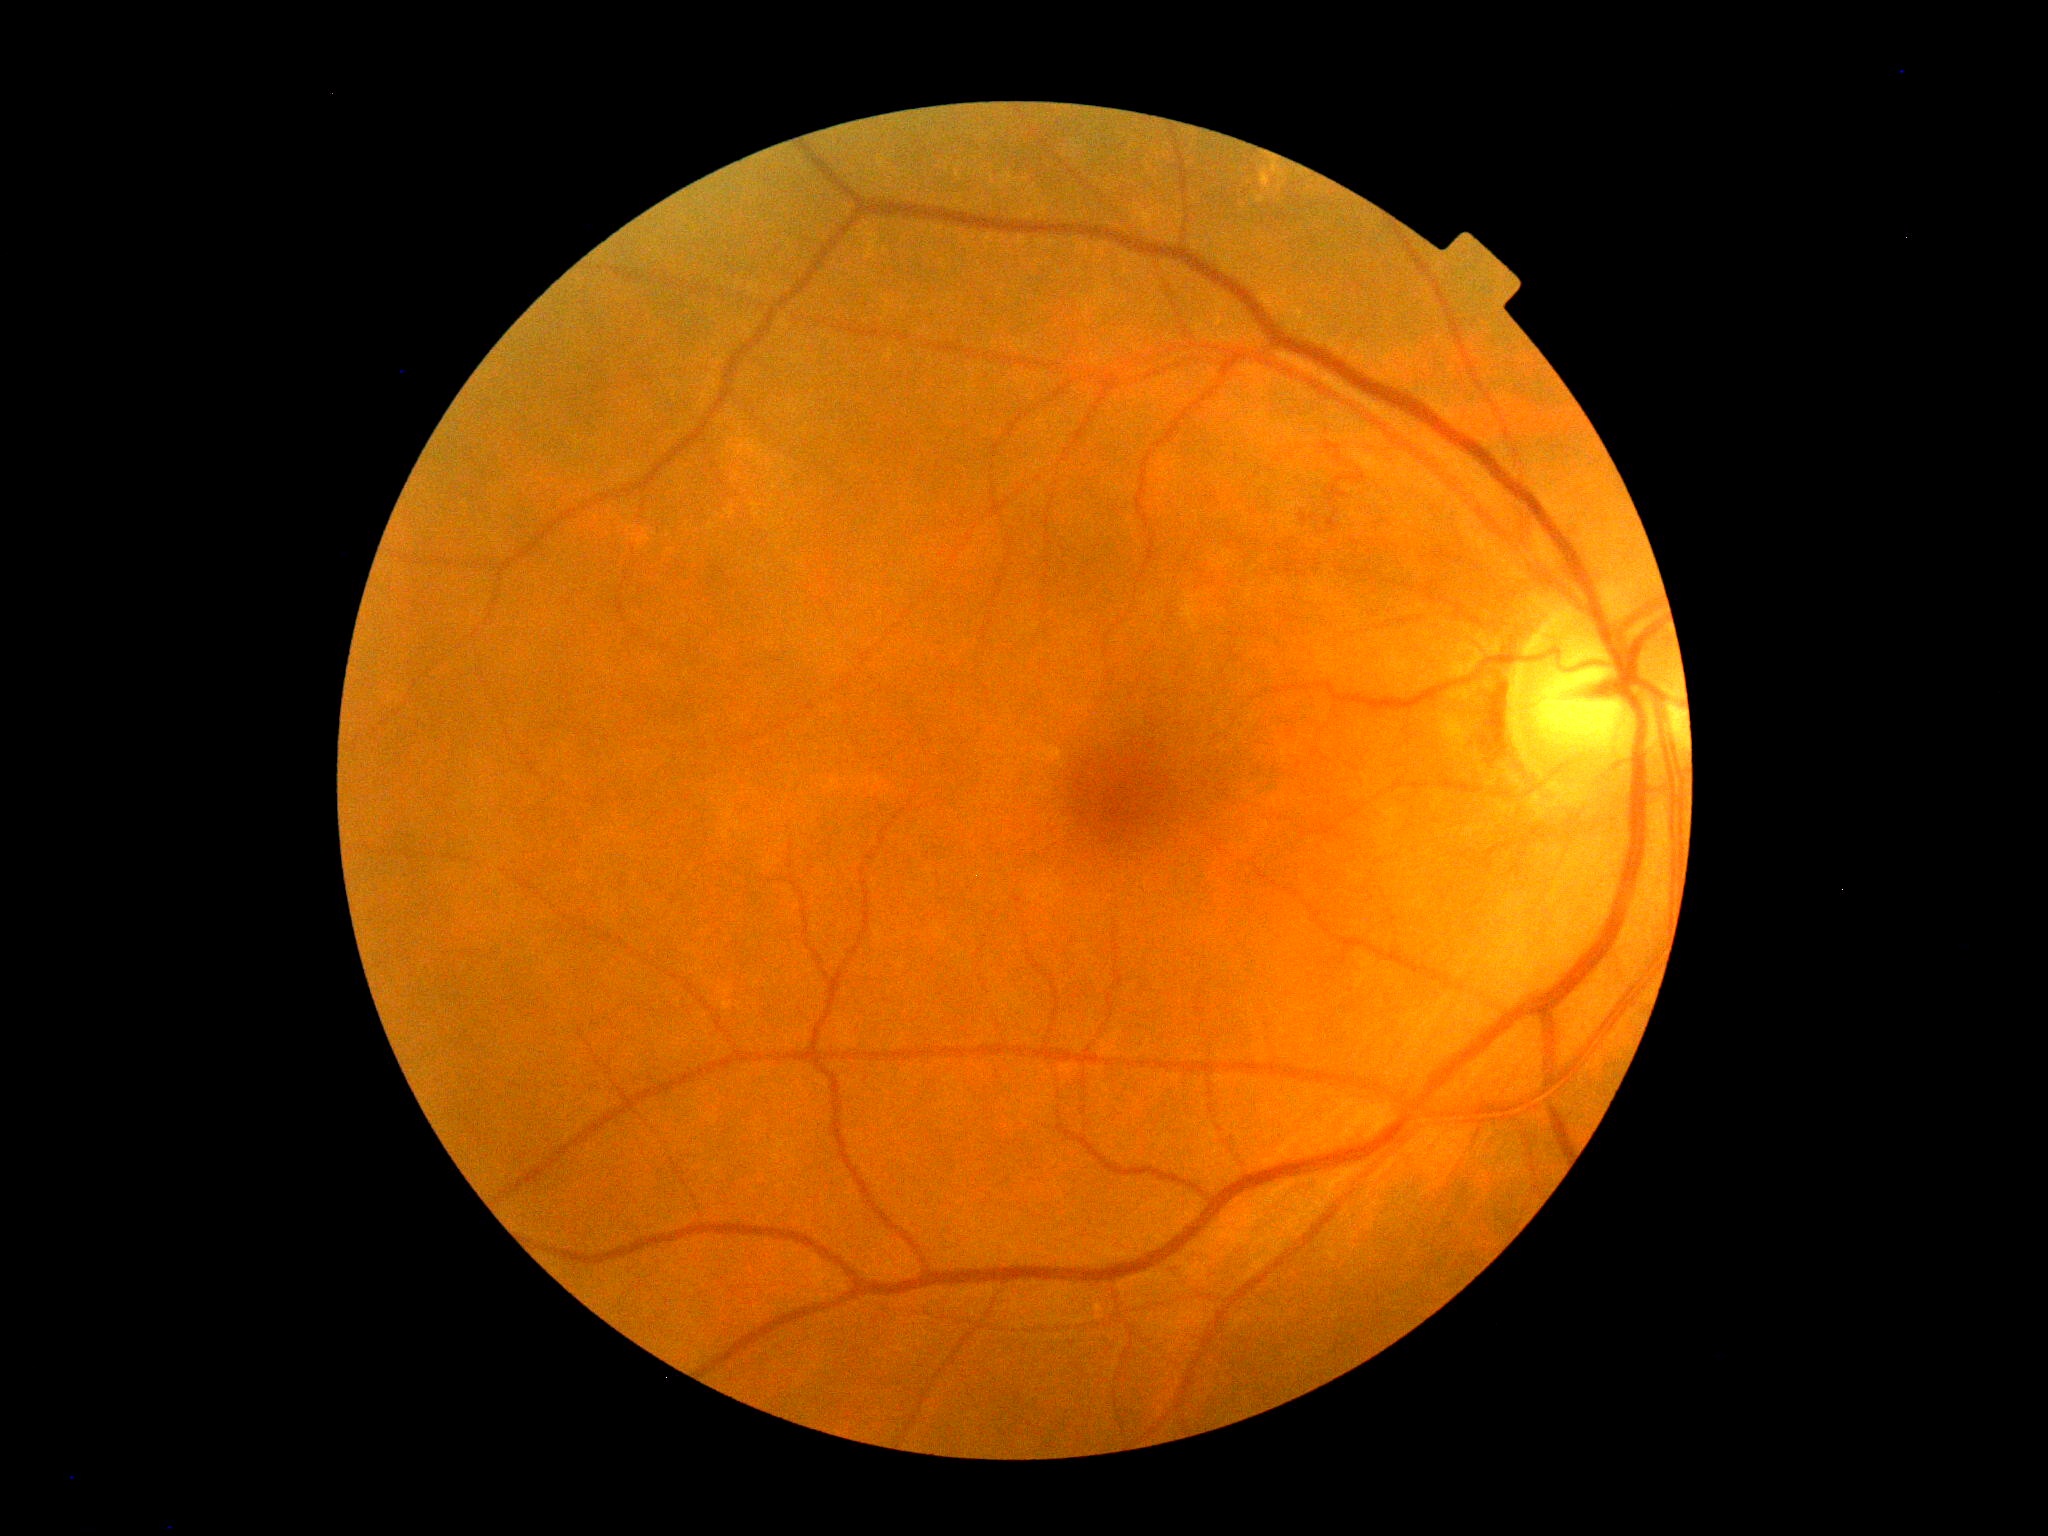
DR is grade 0 (no apparent retinopathy).